Wide-field fundus photograph from neonatal ROP screening: 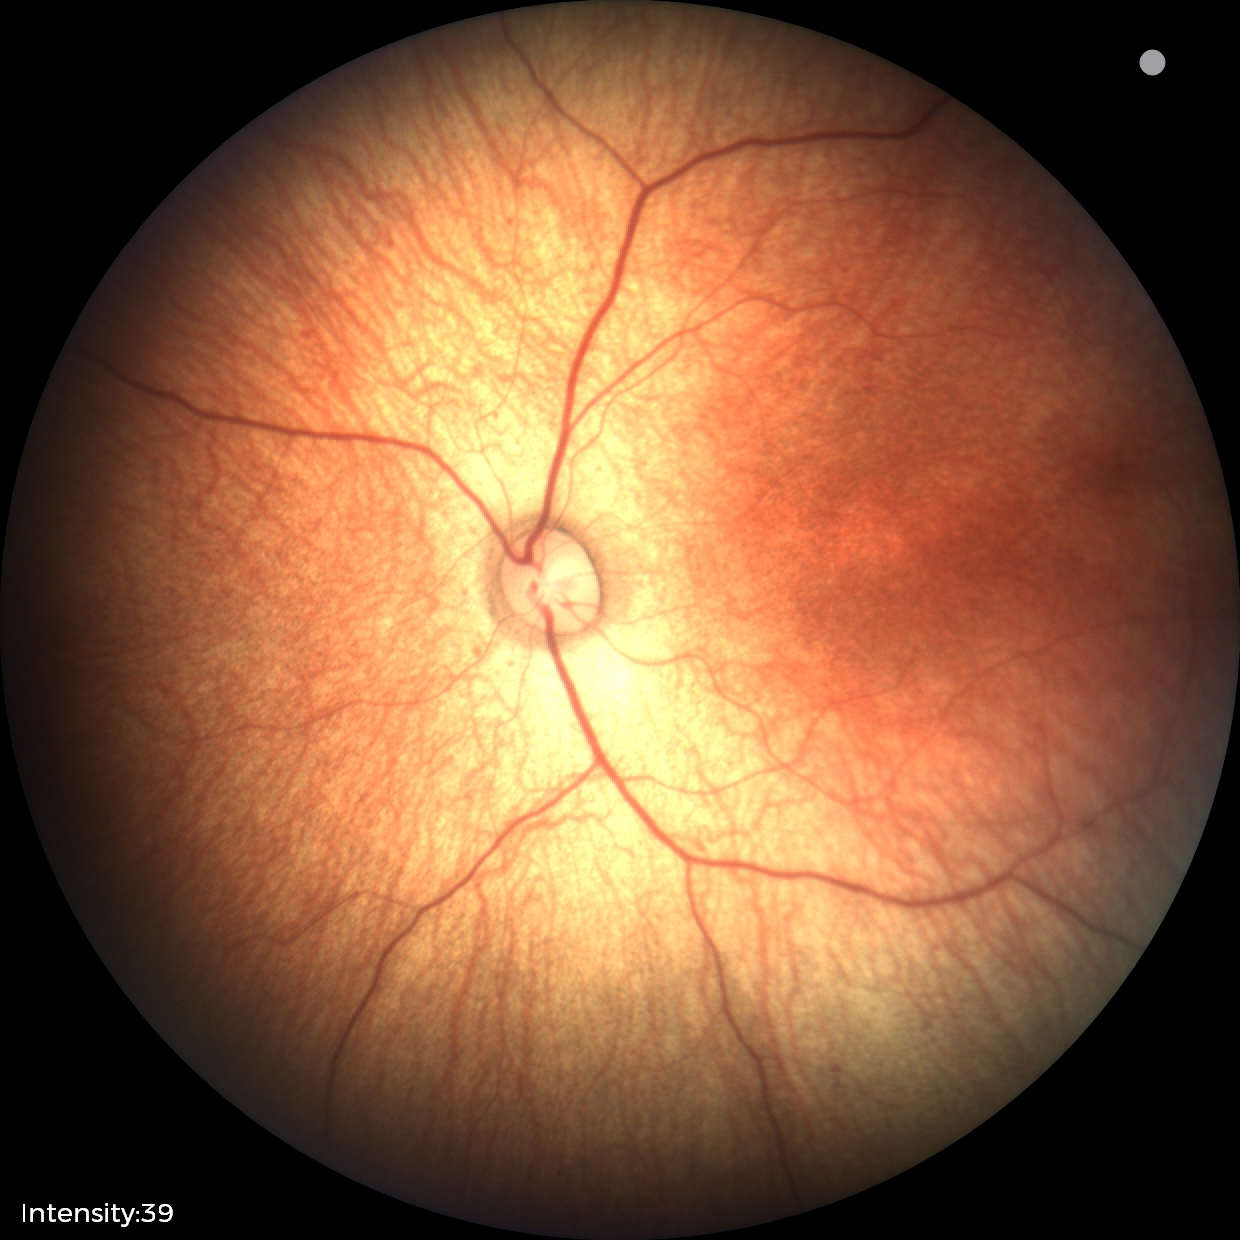 No retinal pathology identified on screening.